2212 x 1659 pixels; color fundus photograph from a handheld portable camera:
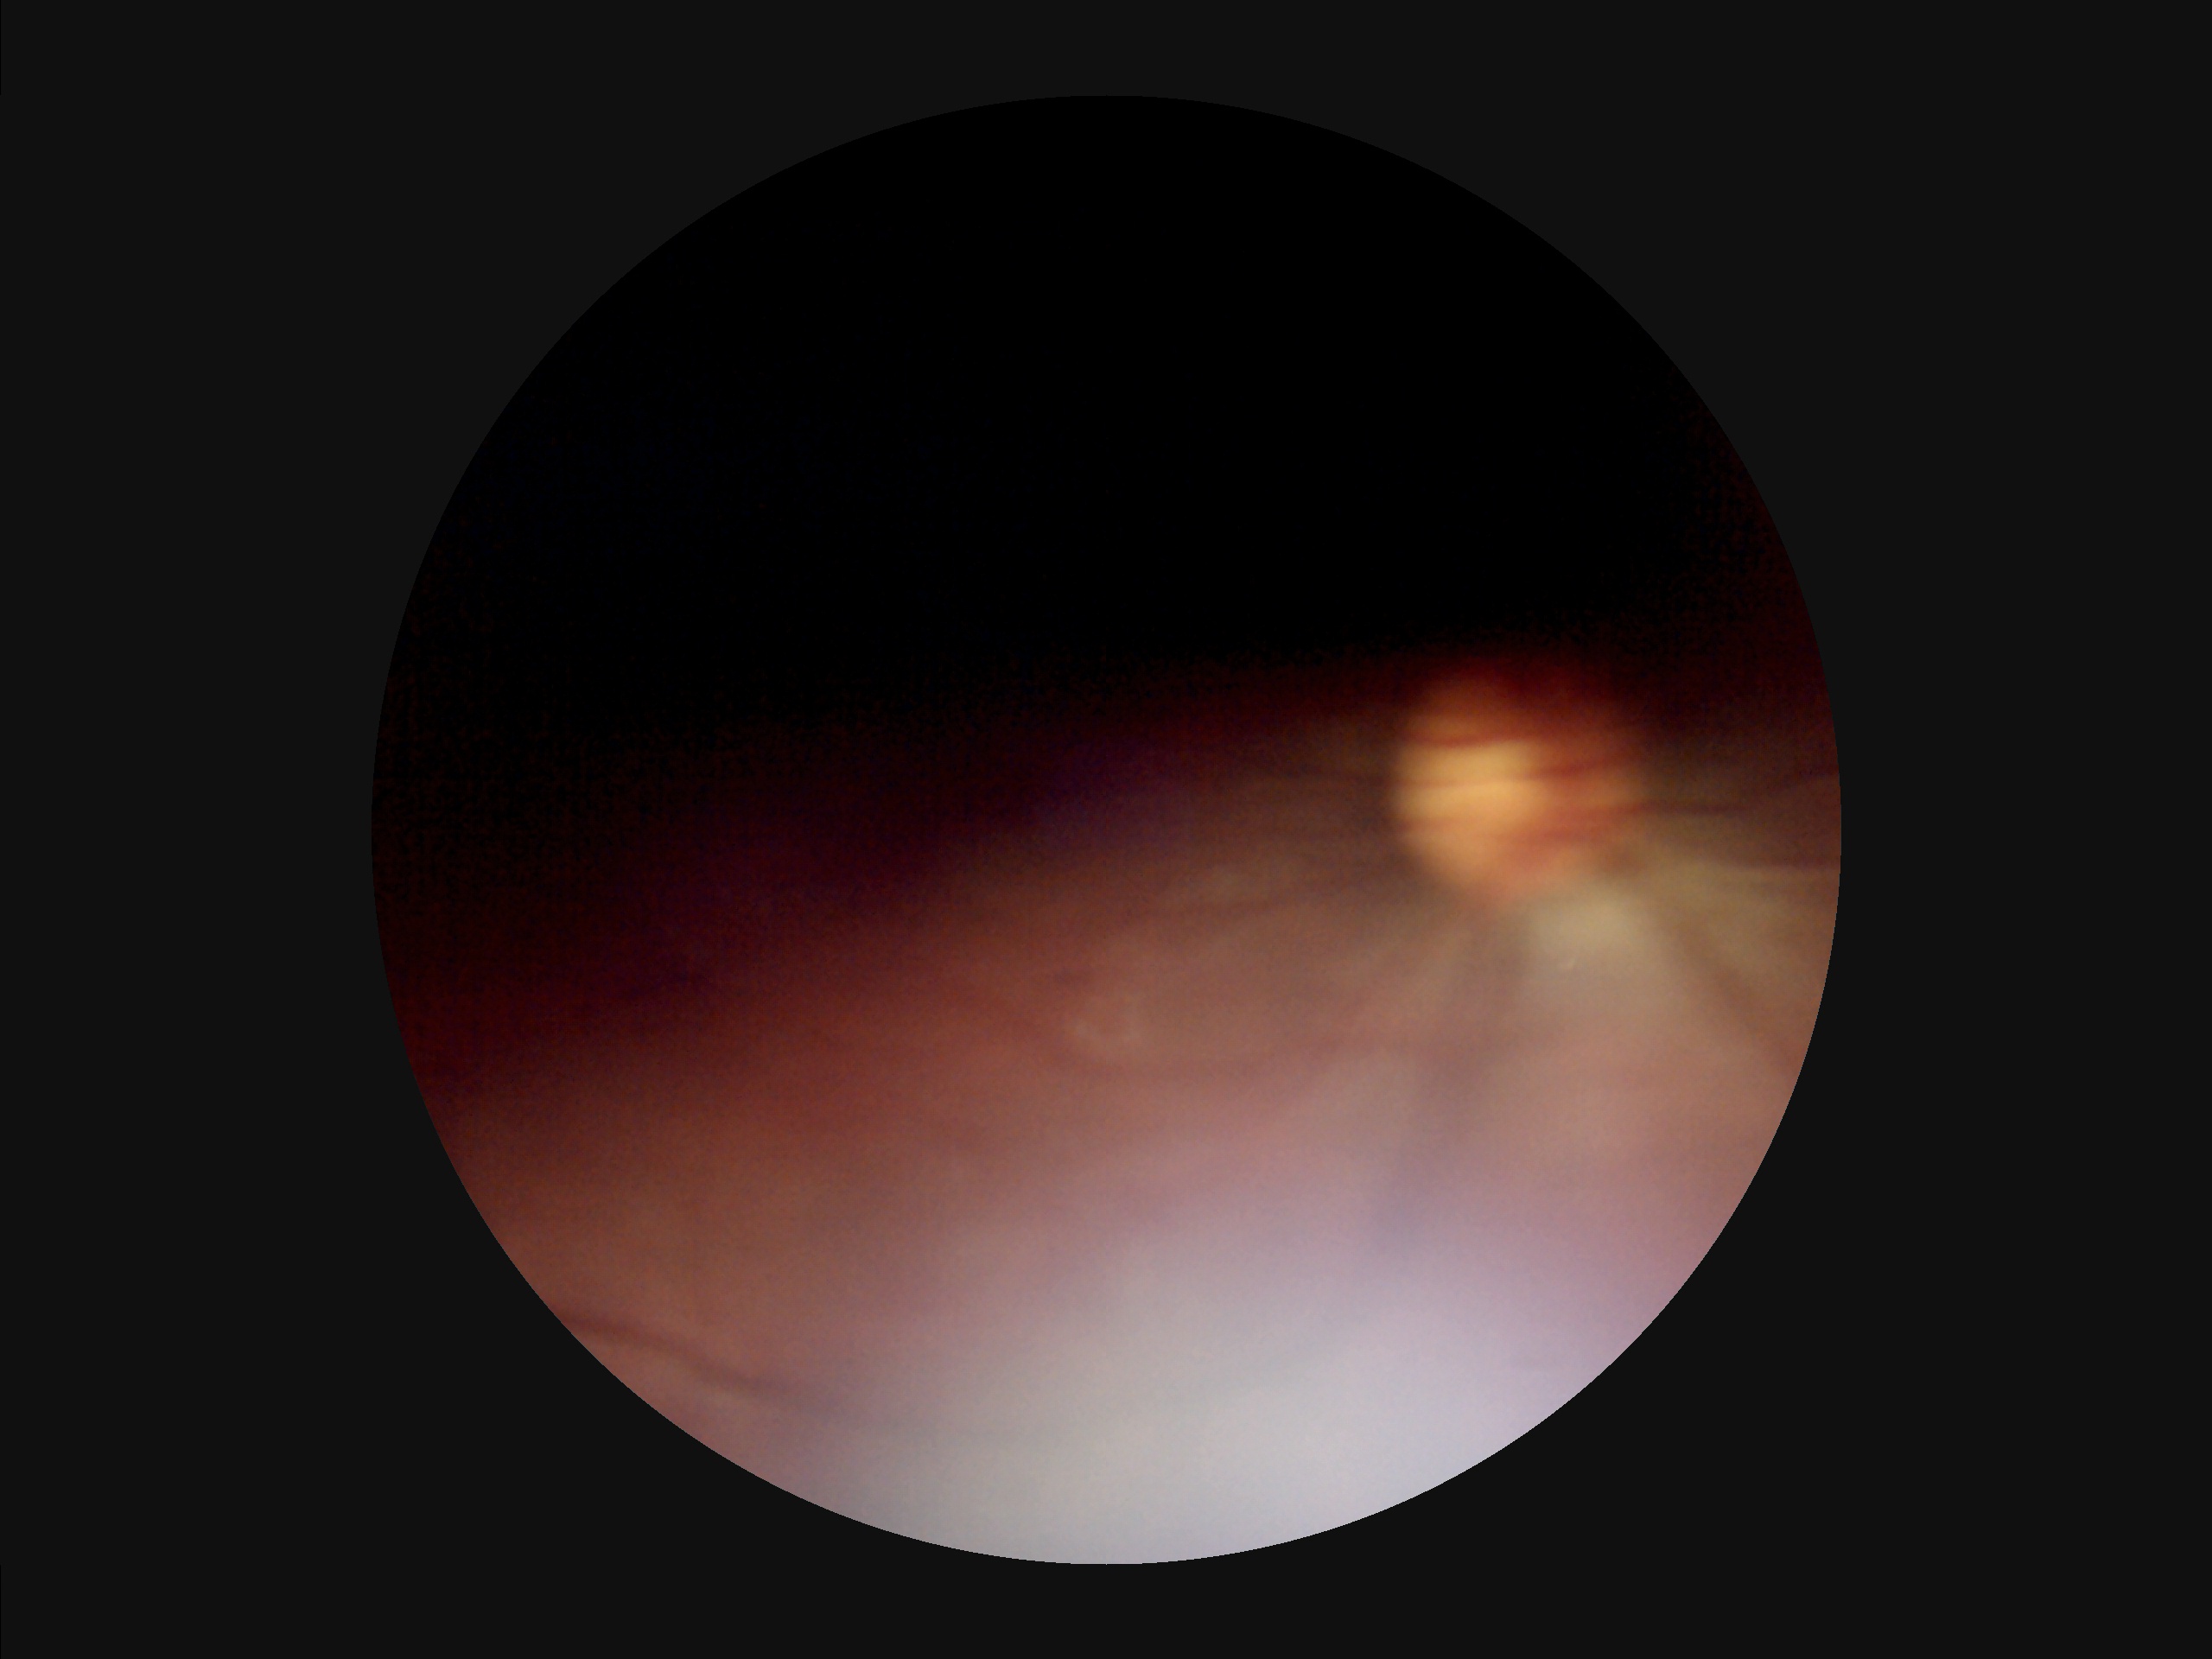
Image quality assessment: illumination/color: uneven illumination or color cast | overall: poor, ungradable | contrast: narrow intensity range, structures hard to distinguish | clarity: noticeable blur in the optic disc, vessels, or background.